Ultra-widefield (UWF) fundus image.
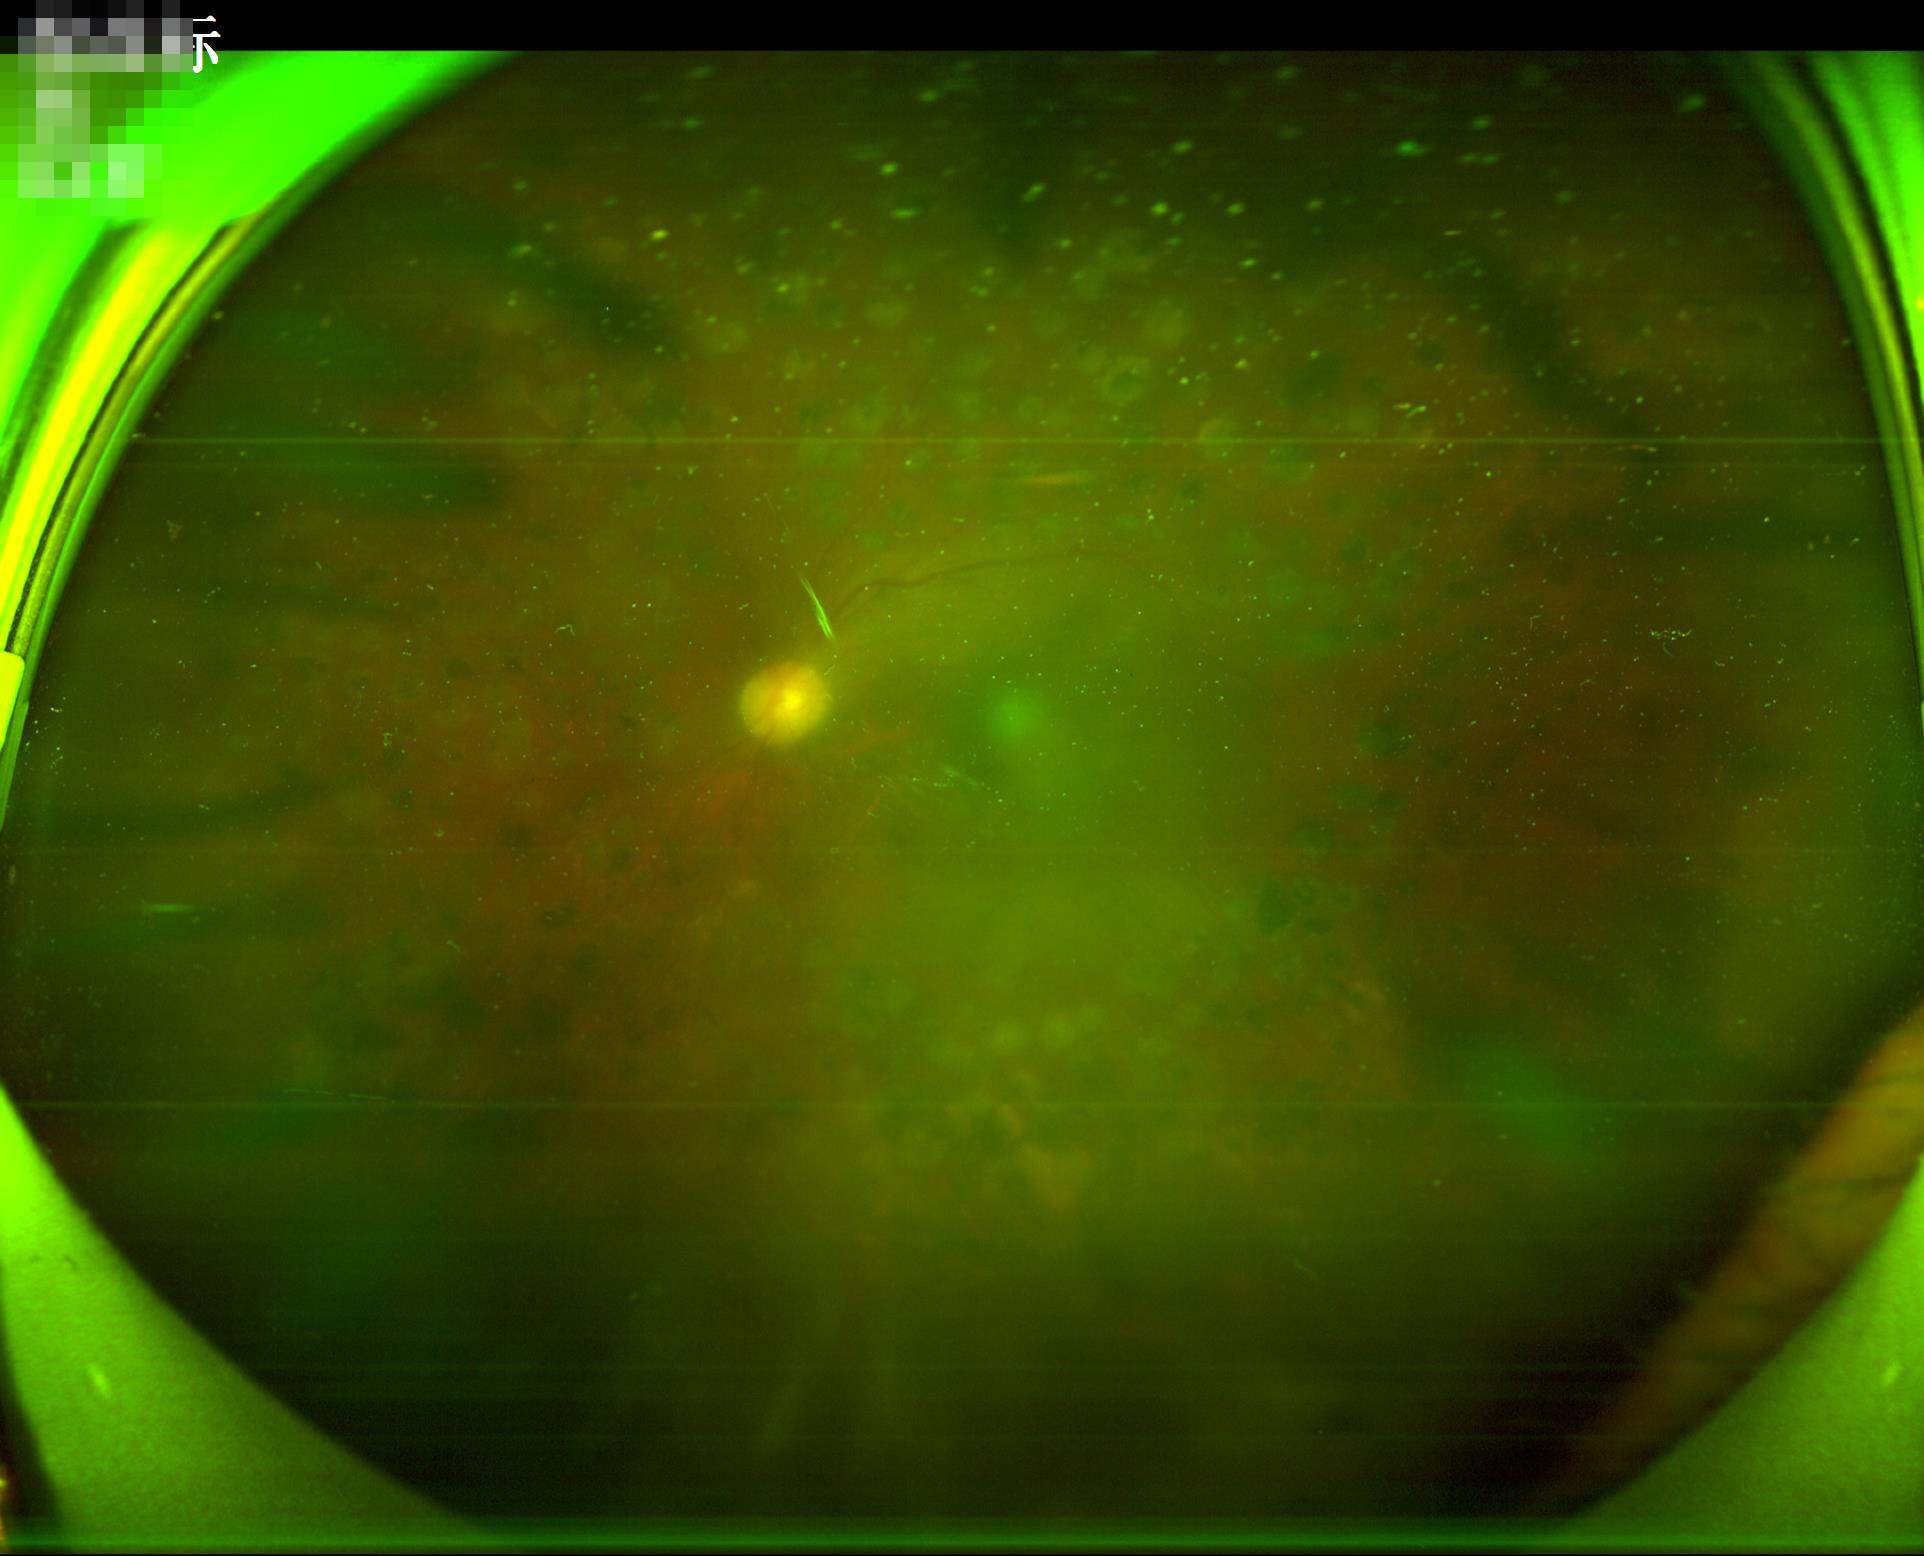

Overall image quality: poor and difficult to use diagnostically | Contrast: poor dynamic range | Clarity: noticeable blur in the optic disc, vessels, or background | Illumination: no over- or under-exposure.